Nonmydriatic, modified Davis grading, 45° FOV.
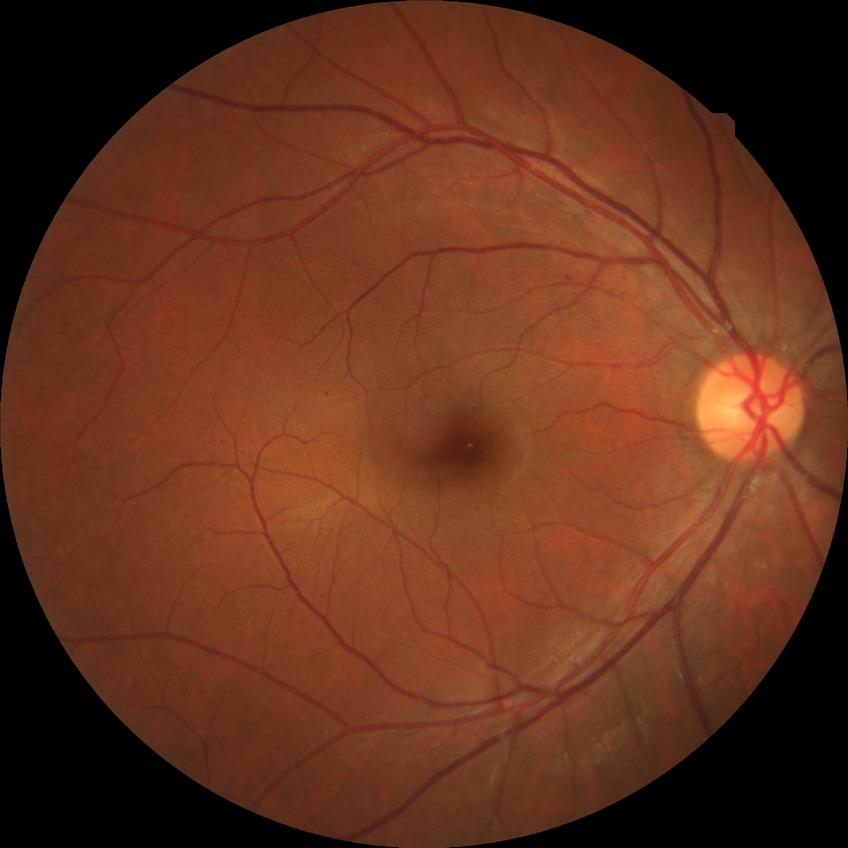 diabetic retinopathy (DR) = simple diabetic retinopathy (SDR).